Camera: NIDEK AFC-230:
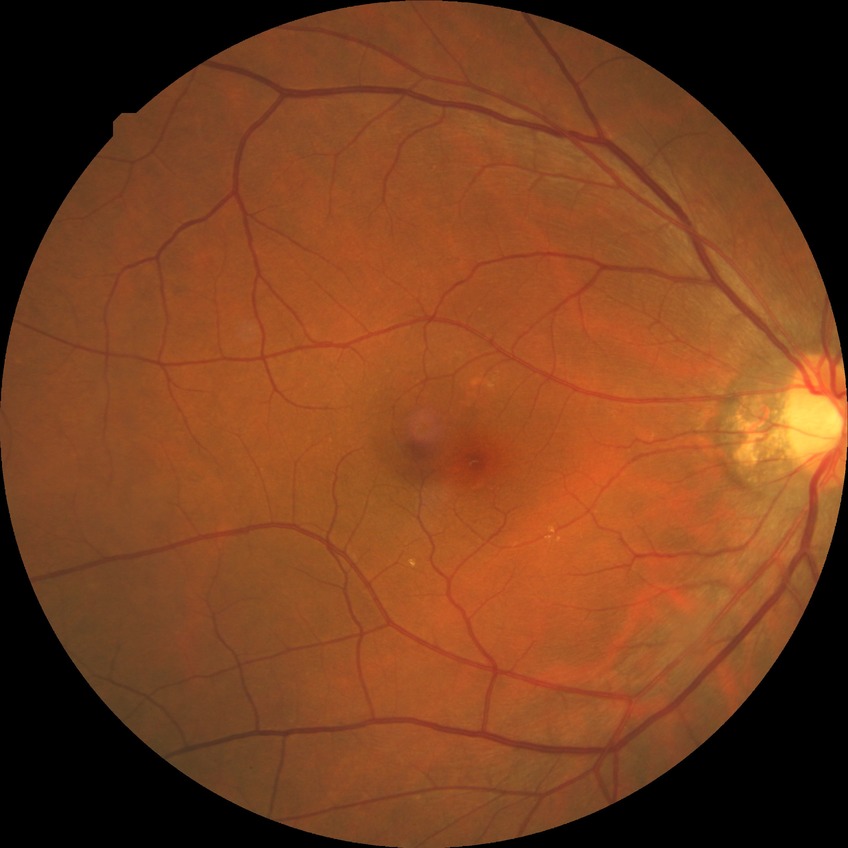

Diabetic retinopathy (DR) is NDR (no diabetic retinopathy).